Optic disc region of a color fundus photo:
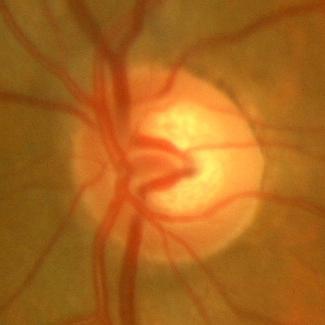

Finding = no glaucomatous findings.